100° field of view (Phoenix ICON) · pediatric wide-field fundus photograph · image size 1240x1240 — 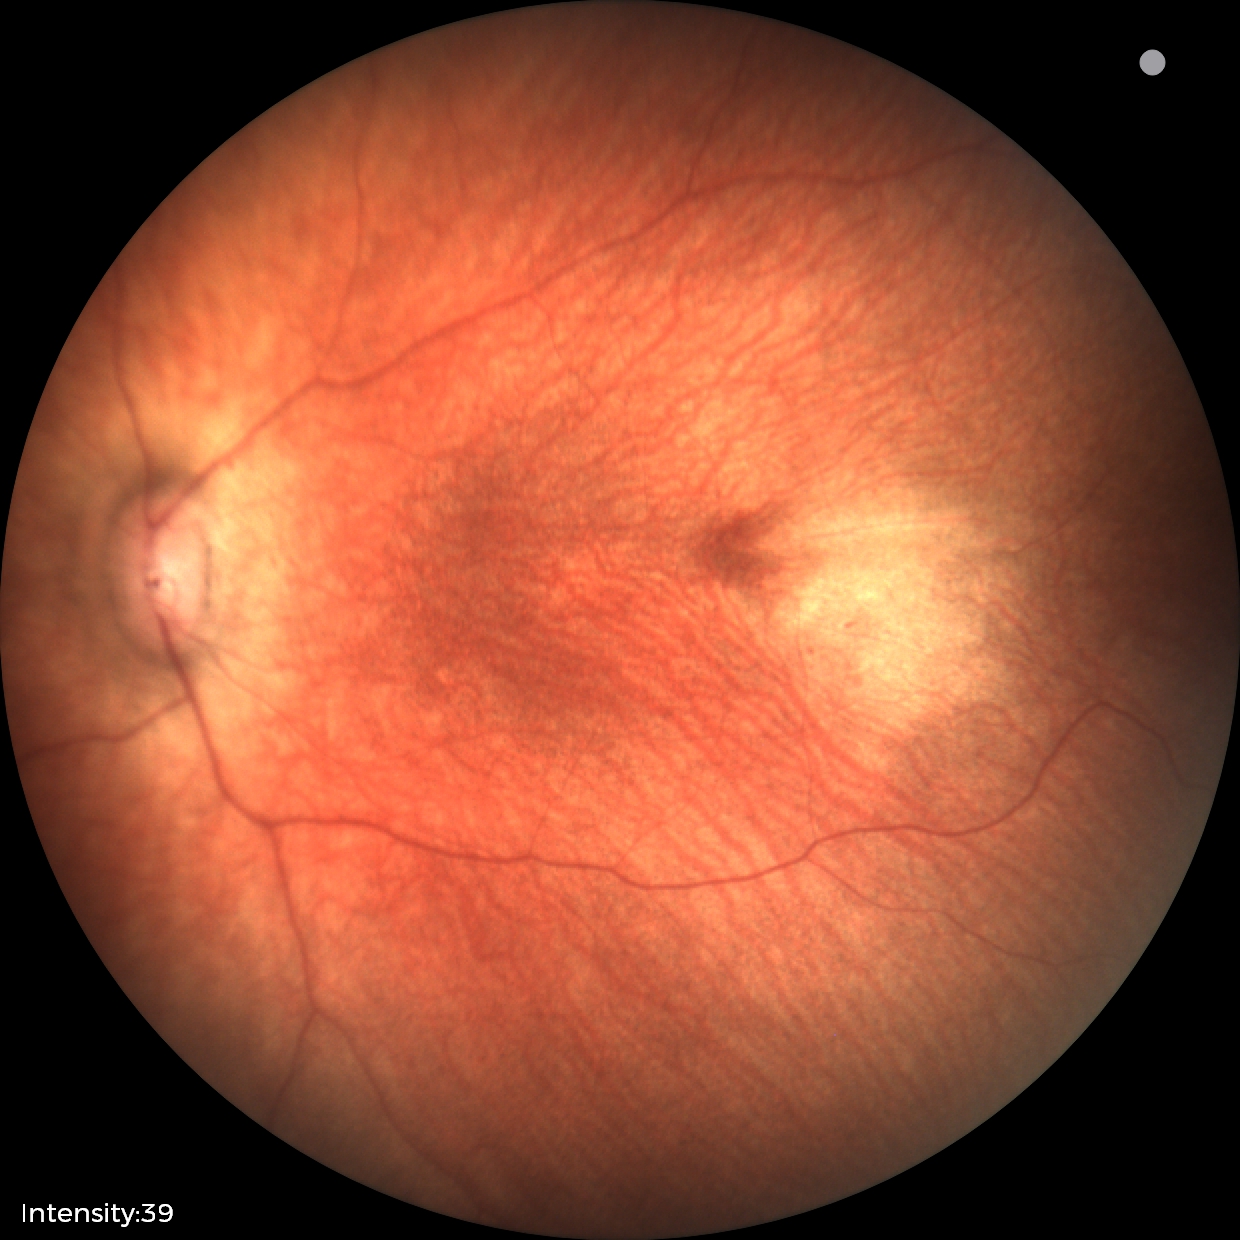
Diagnosis: normal